1932x1910px. Color fundus image: 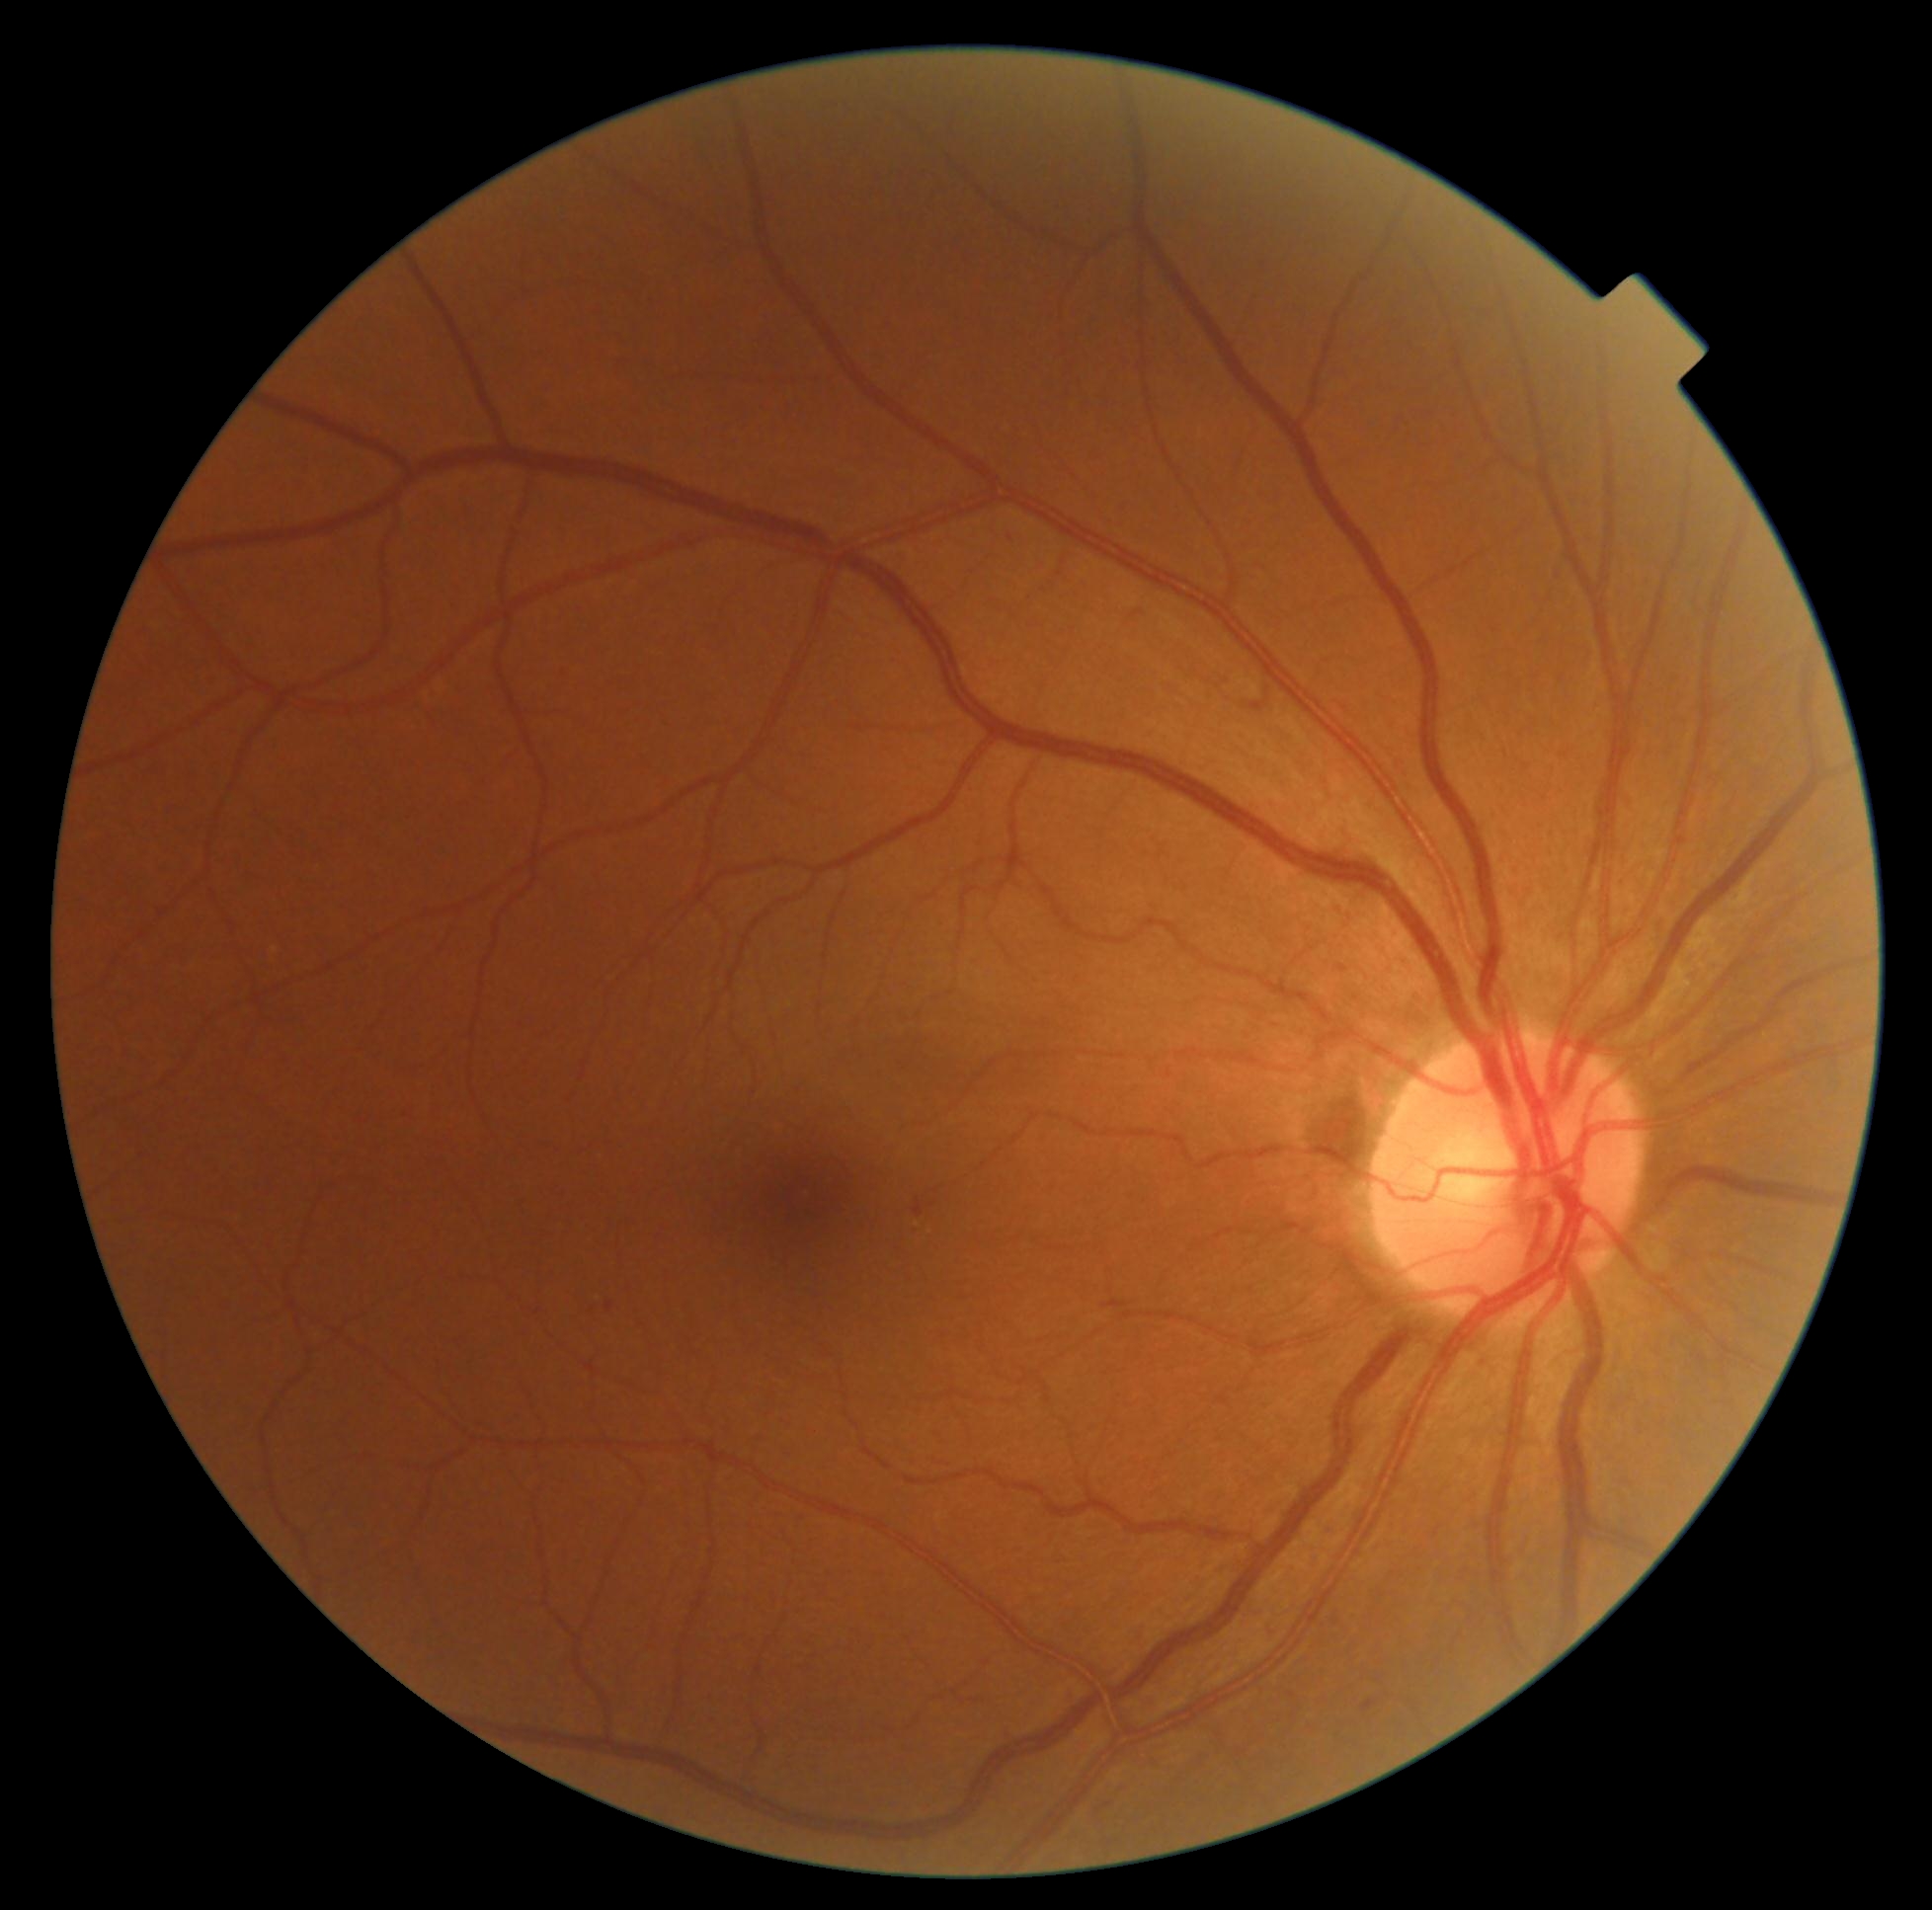 DR severity: grade 2 (moderate NPDR), DR class: non-proliferative diabetic retinopathy.